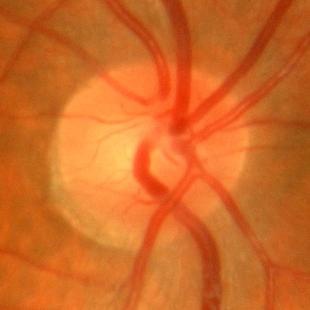

Q: Is there glaucomatous optic neuropathy?
A: No — no evidence of glaucoma.